Fundus photo
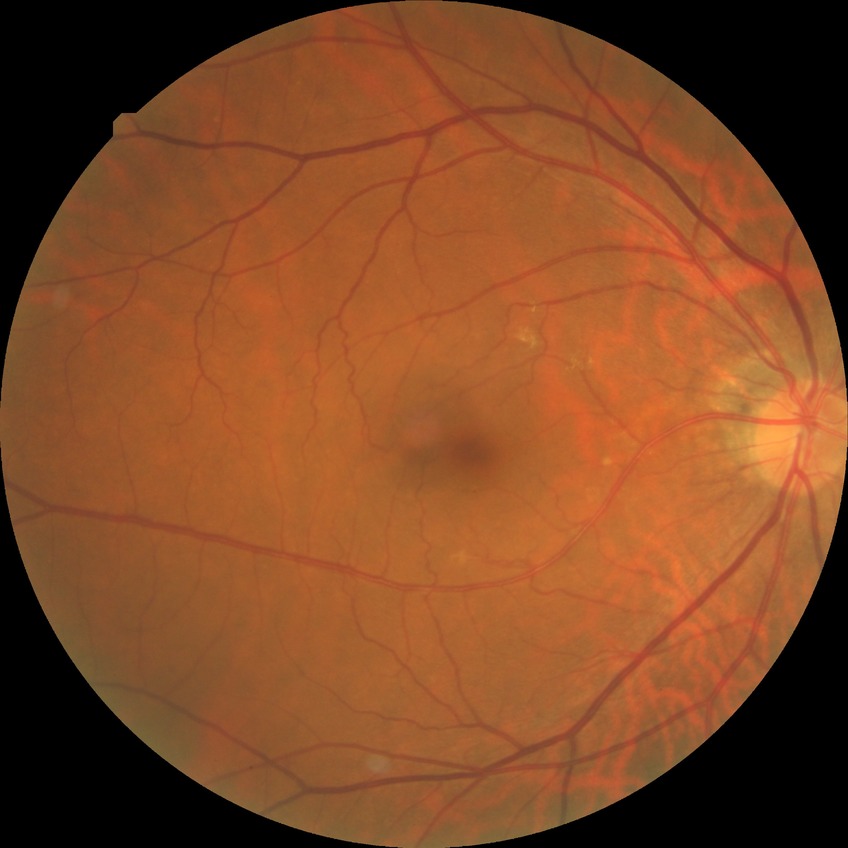

Davis grading: no diabetic retinopathy.